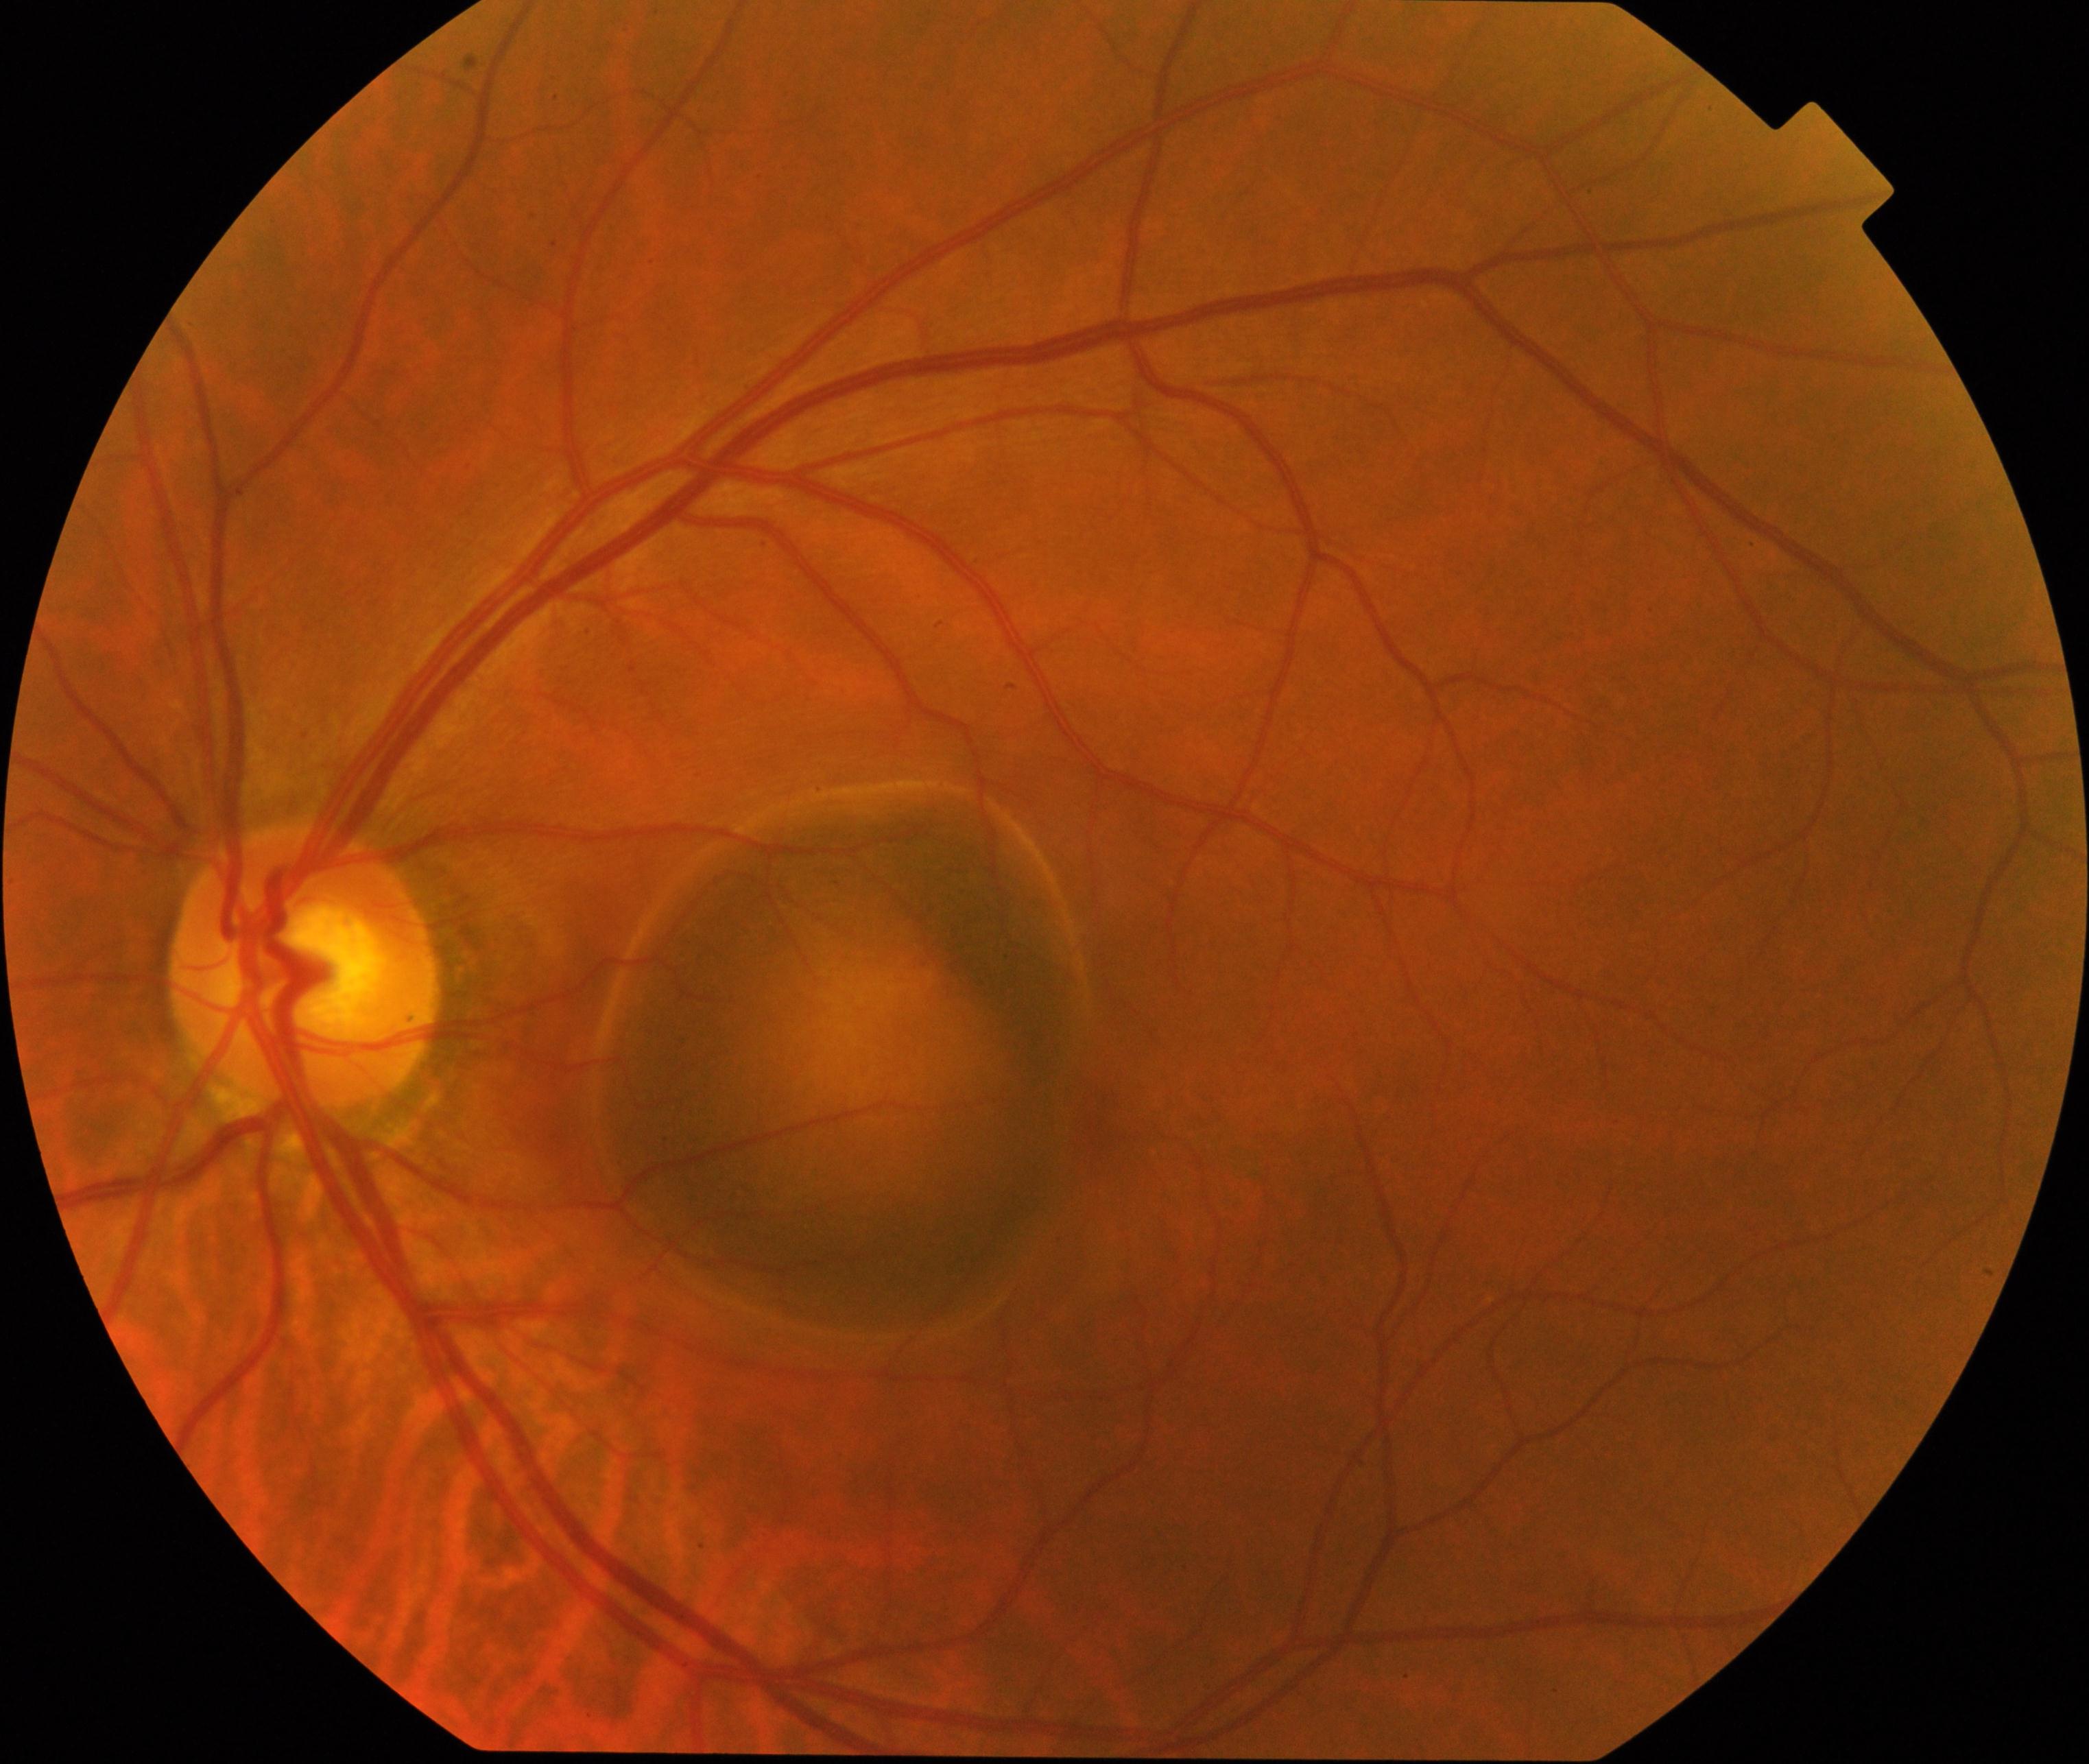
Findings consistent with maculopathy.